Image size 2048x1536. FOV: 45 degrees:
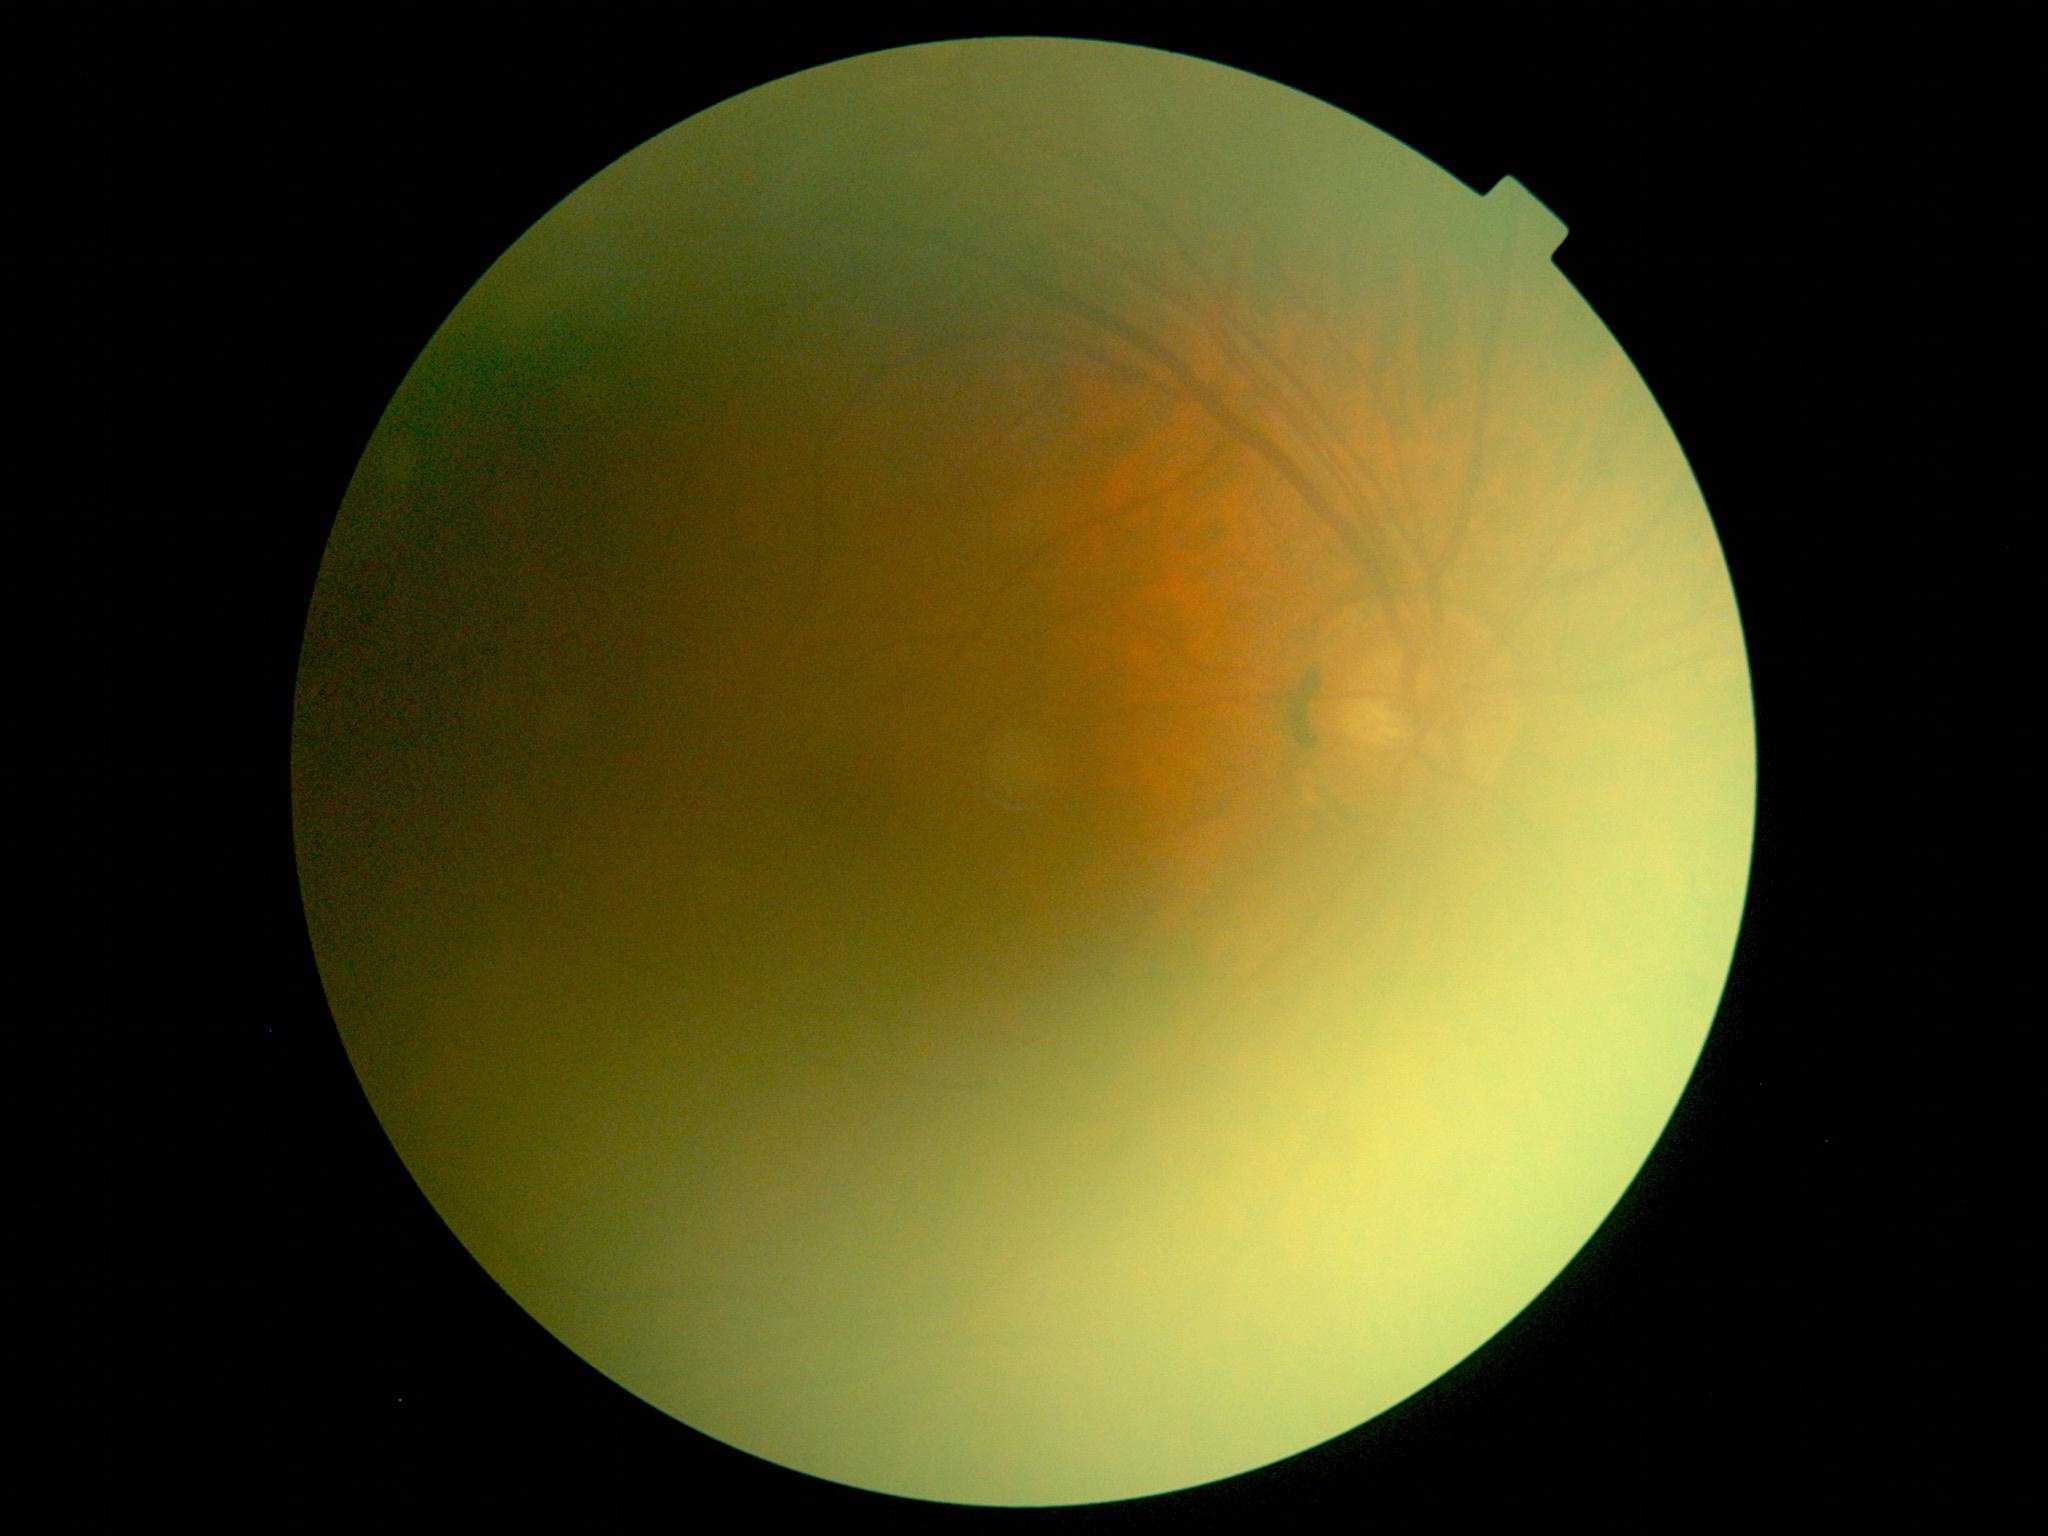 No diabetic retinal disease findings.
Diabetic retinopathy grade: 0 (no apparent retinopathy) — no visible signs of diabetic retinopathy.